848 x 848 pixels · 45° FOV · DR severity per modified Davis staging.
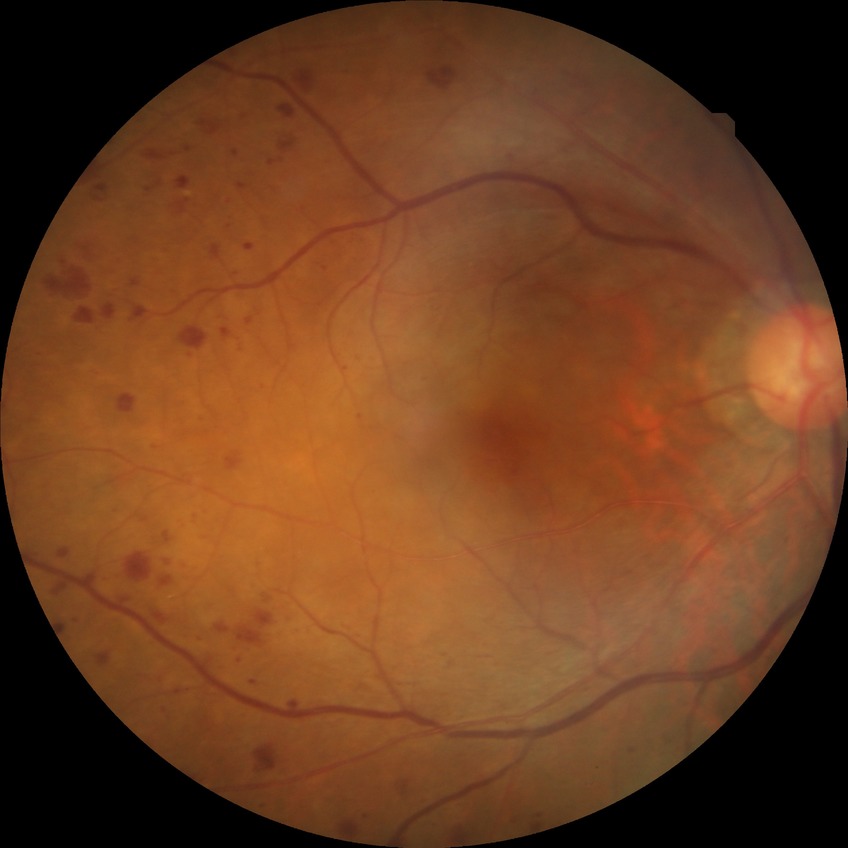
Diabetic retinopathy (DR) is simple diabetic retinopathy (SDR).